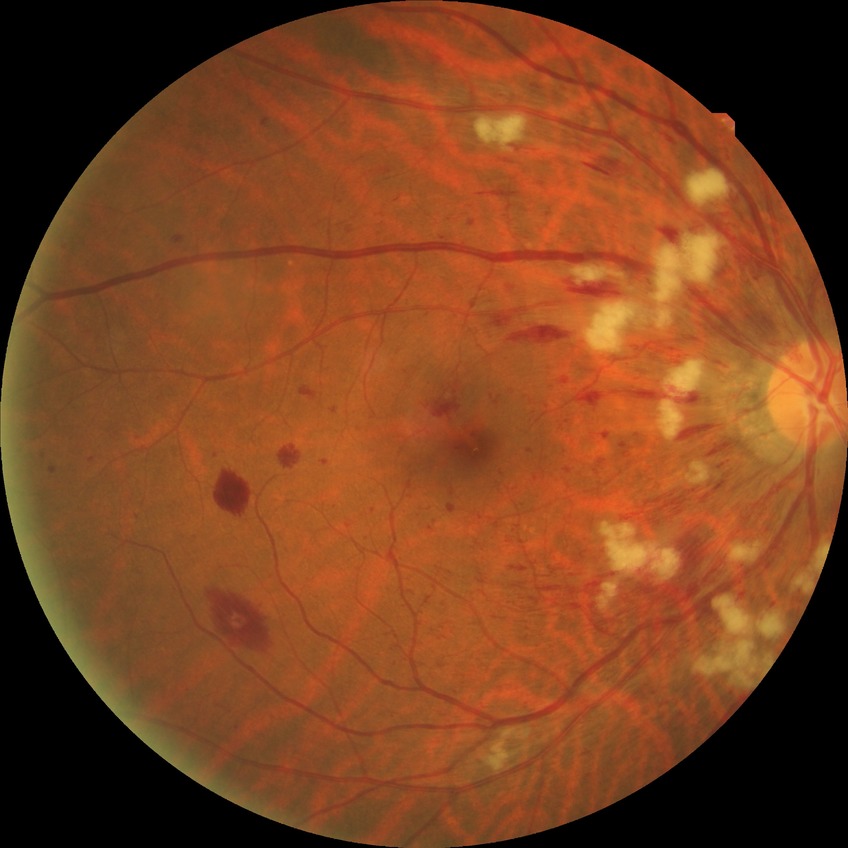
{"davis_grade": "PPDR (pre-proliferative diabetic retinopathy)", "proliferative_class": "non-proliferative diabetic retinopathy"}